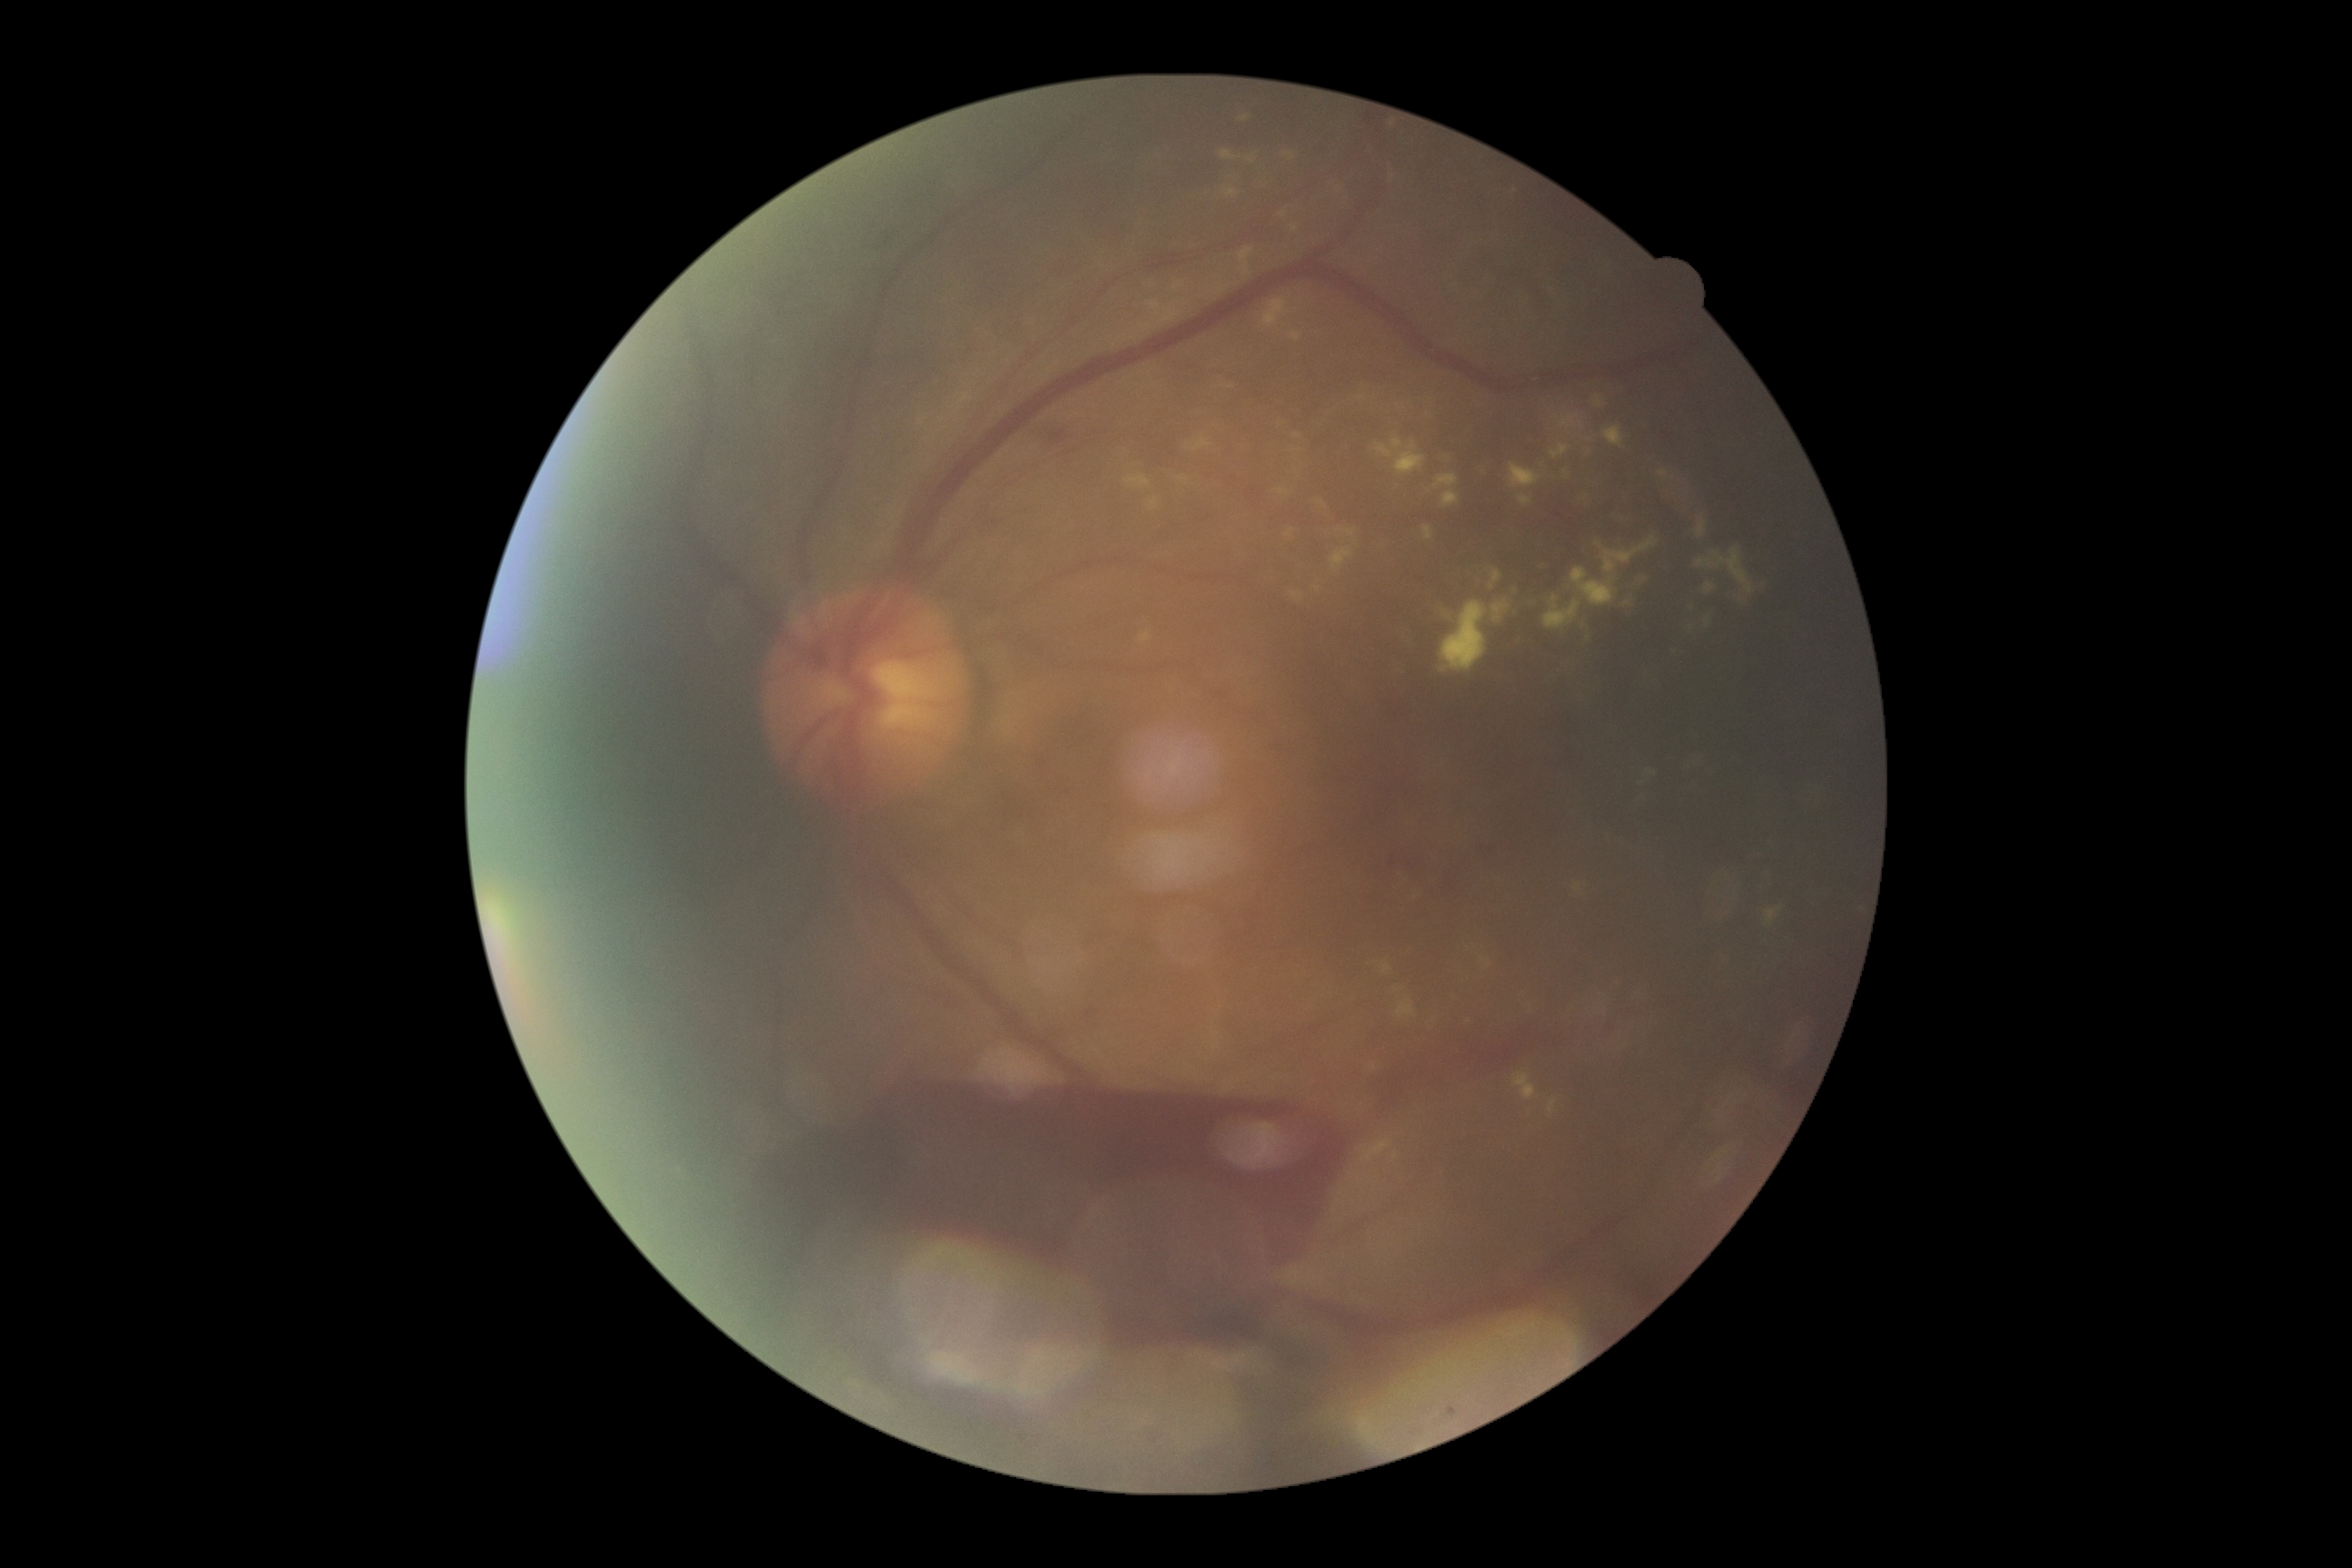 DR grade is PDR (4) — neovascularization and/or vitreous/pre-retinal hemorrhage.